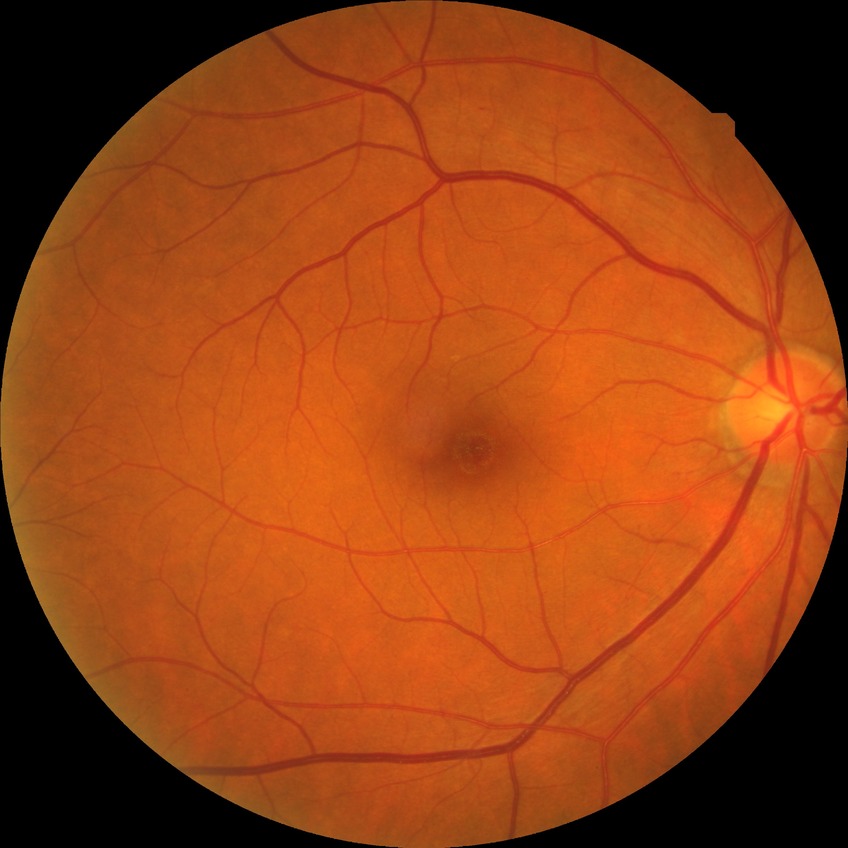 diabetic retinopathy (DR) = NDR (no diabetic retinopathy).